45-degree field of view
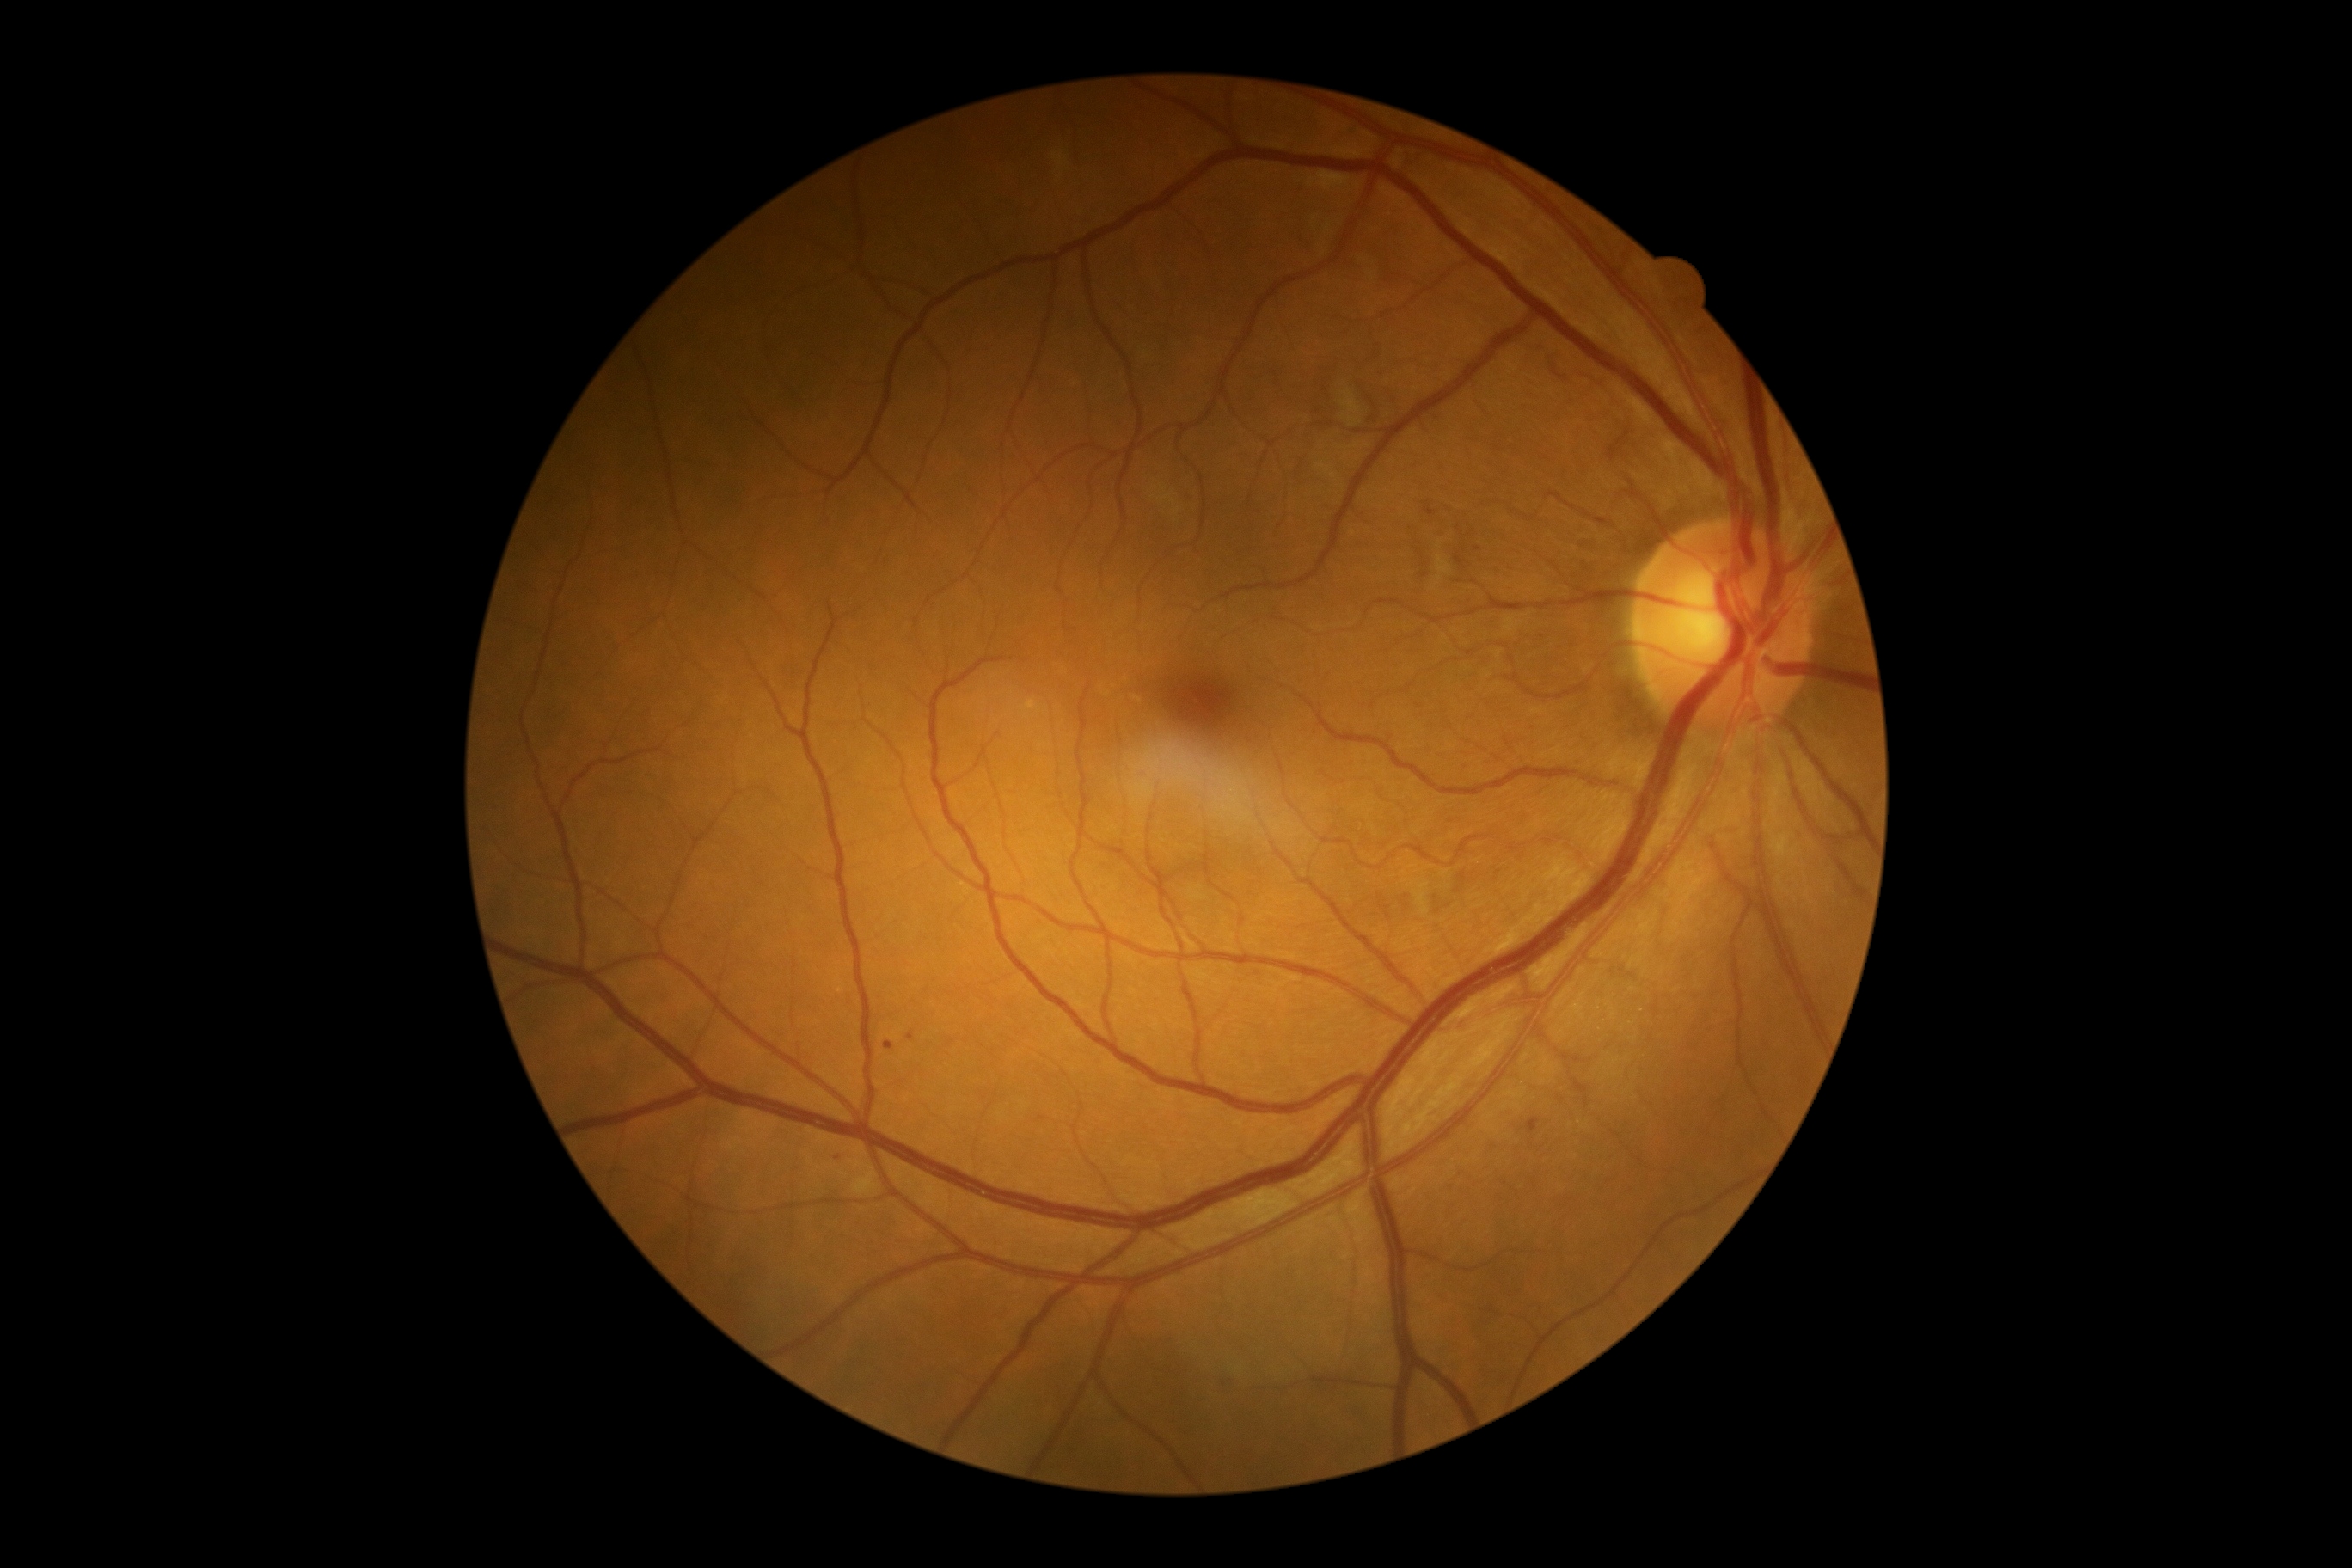

Retinopathy is 2
soft exudates: (1340, 384, 1366, 429); (1416, 883, 1430, 916); (1438, 541, 1442, 549); (852, 1165, 879, 1196); (1051, 149, 1072, 176); (1146, 481, 1185, 515); (1438, 554, 1454, 580)
Additional small soft exudates near [x=1435, y=586]
microaneurysms: (1526, 1118, 1541, 1136); (1225, 1381, 1228, 1390); (836, 1155, 845, 1161); (1455, 556, 1466, 568); (1424, 503, 1438, 517); (885, 1041, 895, 1050); (907, 1032, 916, 1041)
Additional small microaneurysms near [x=1477, y=549]
hemorrhages: none detected
hard exudates: none detected